45° field of view:
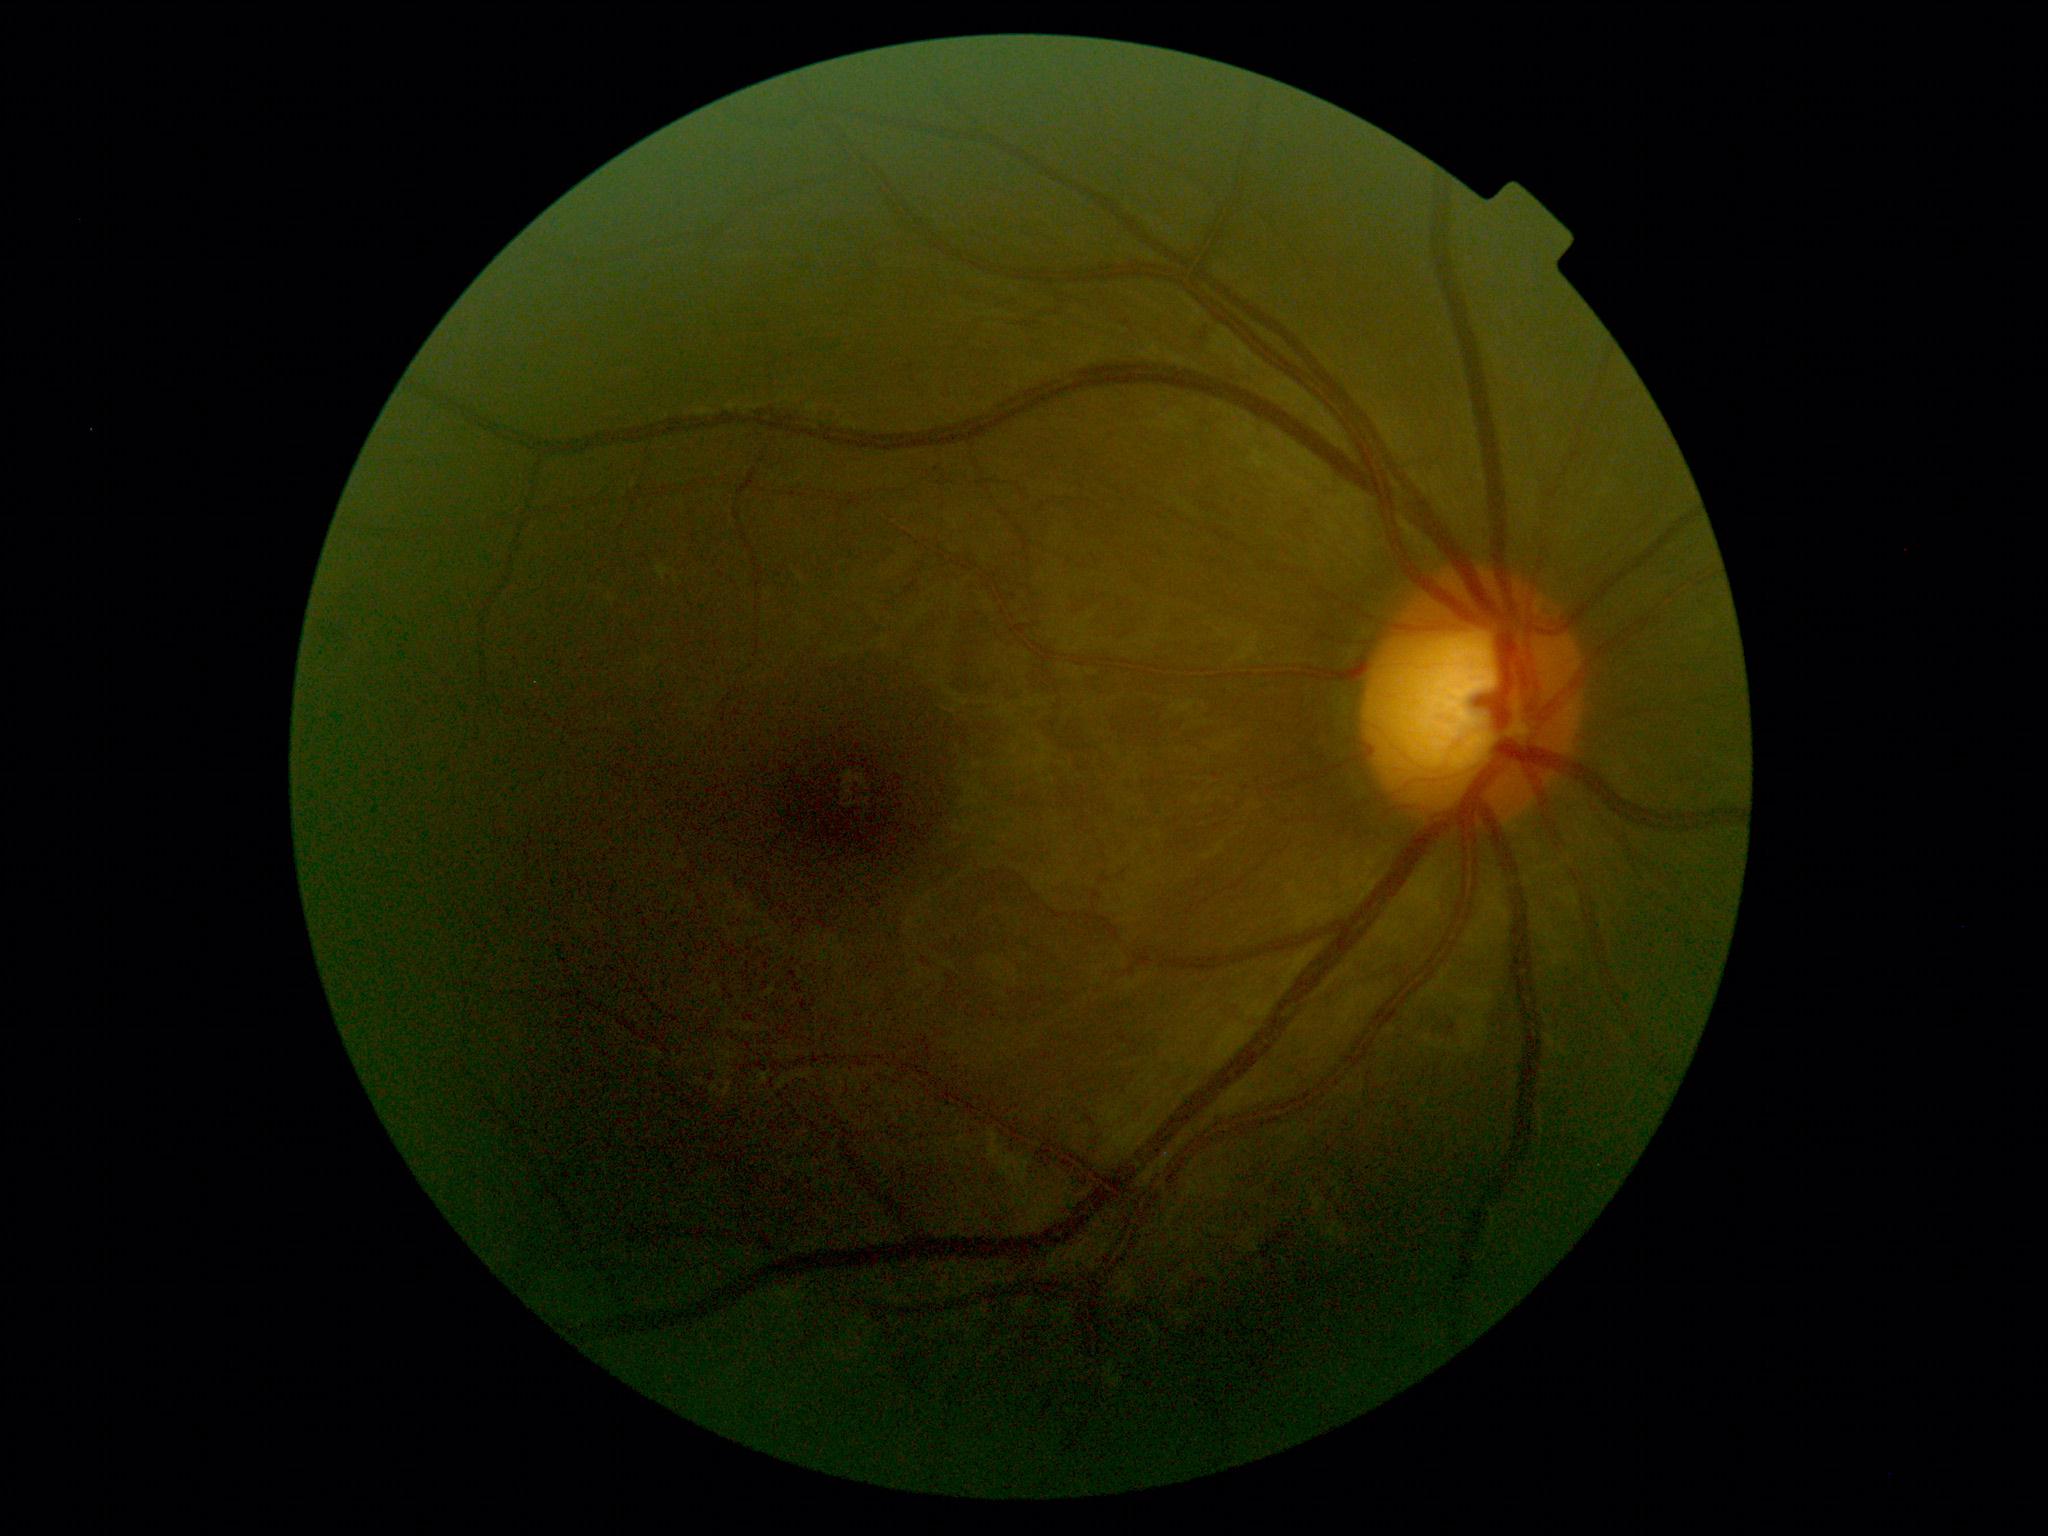
Retinopathy: no apparent retinopathy (grade 0).